Retinal fundus photograph. 2352 by 1568 pixels: 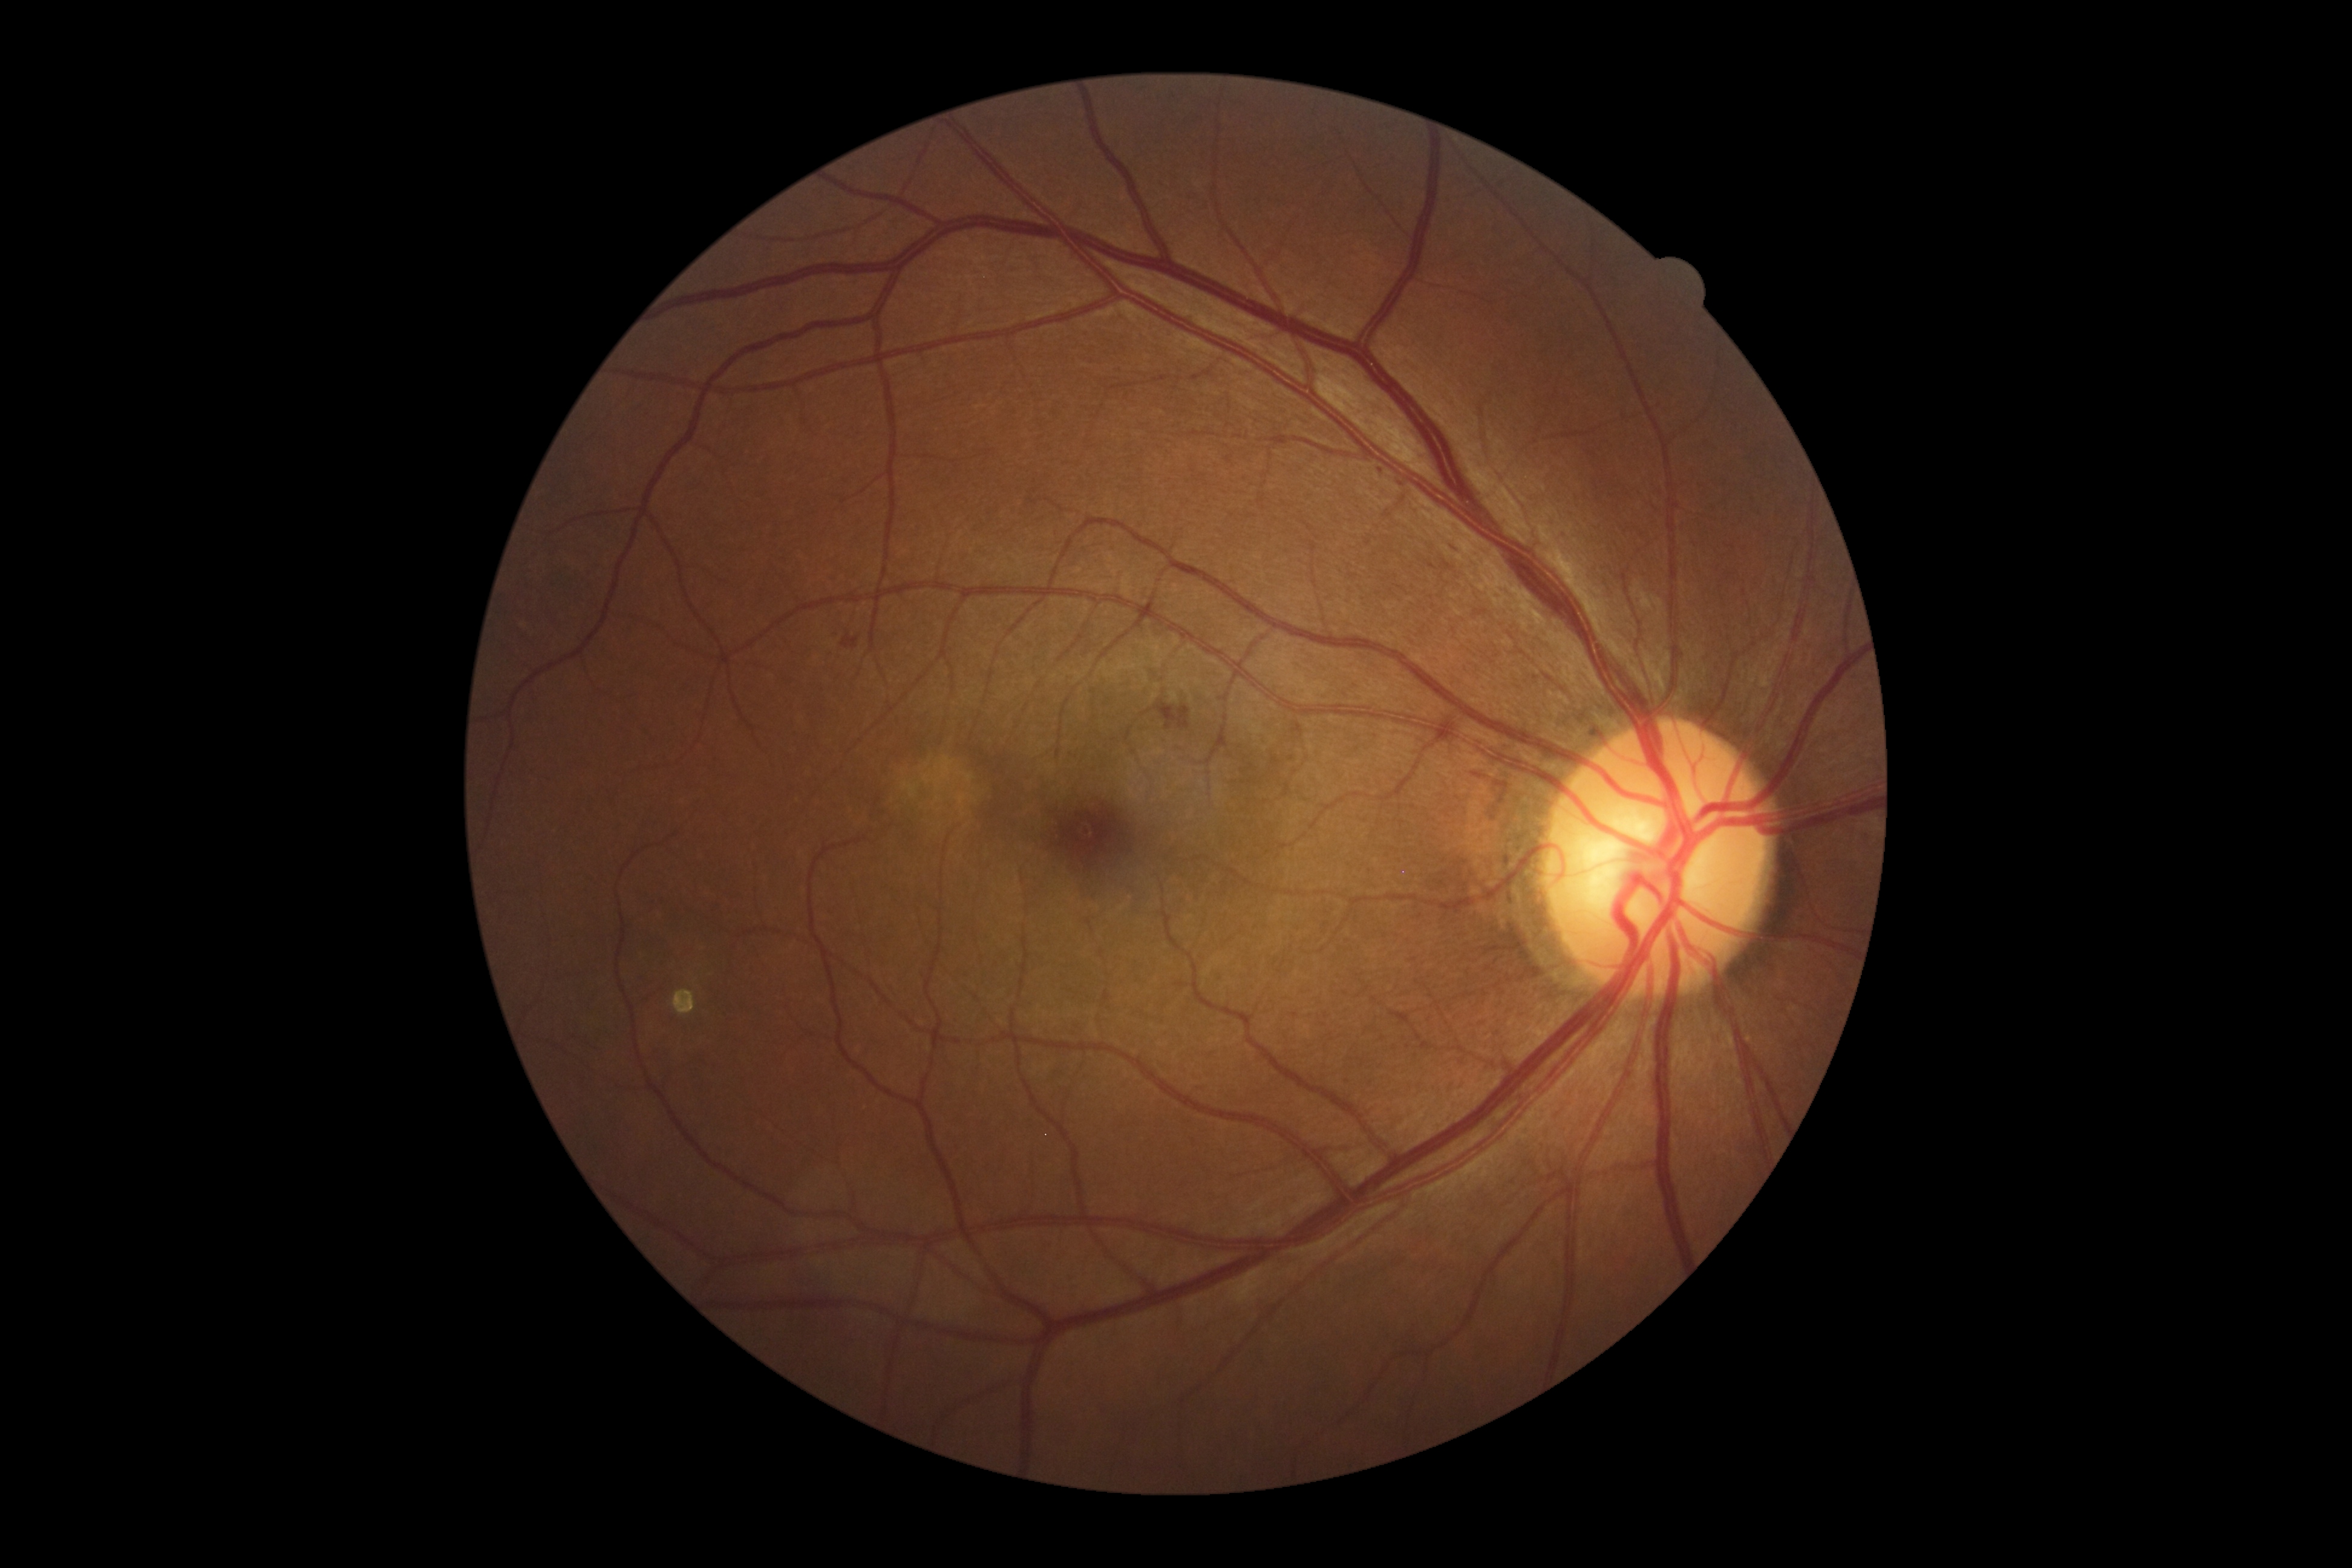

Diabetic retinopathy is grade 2.